Portable fundus photograph
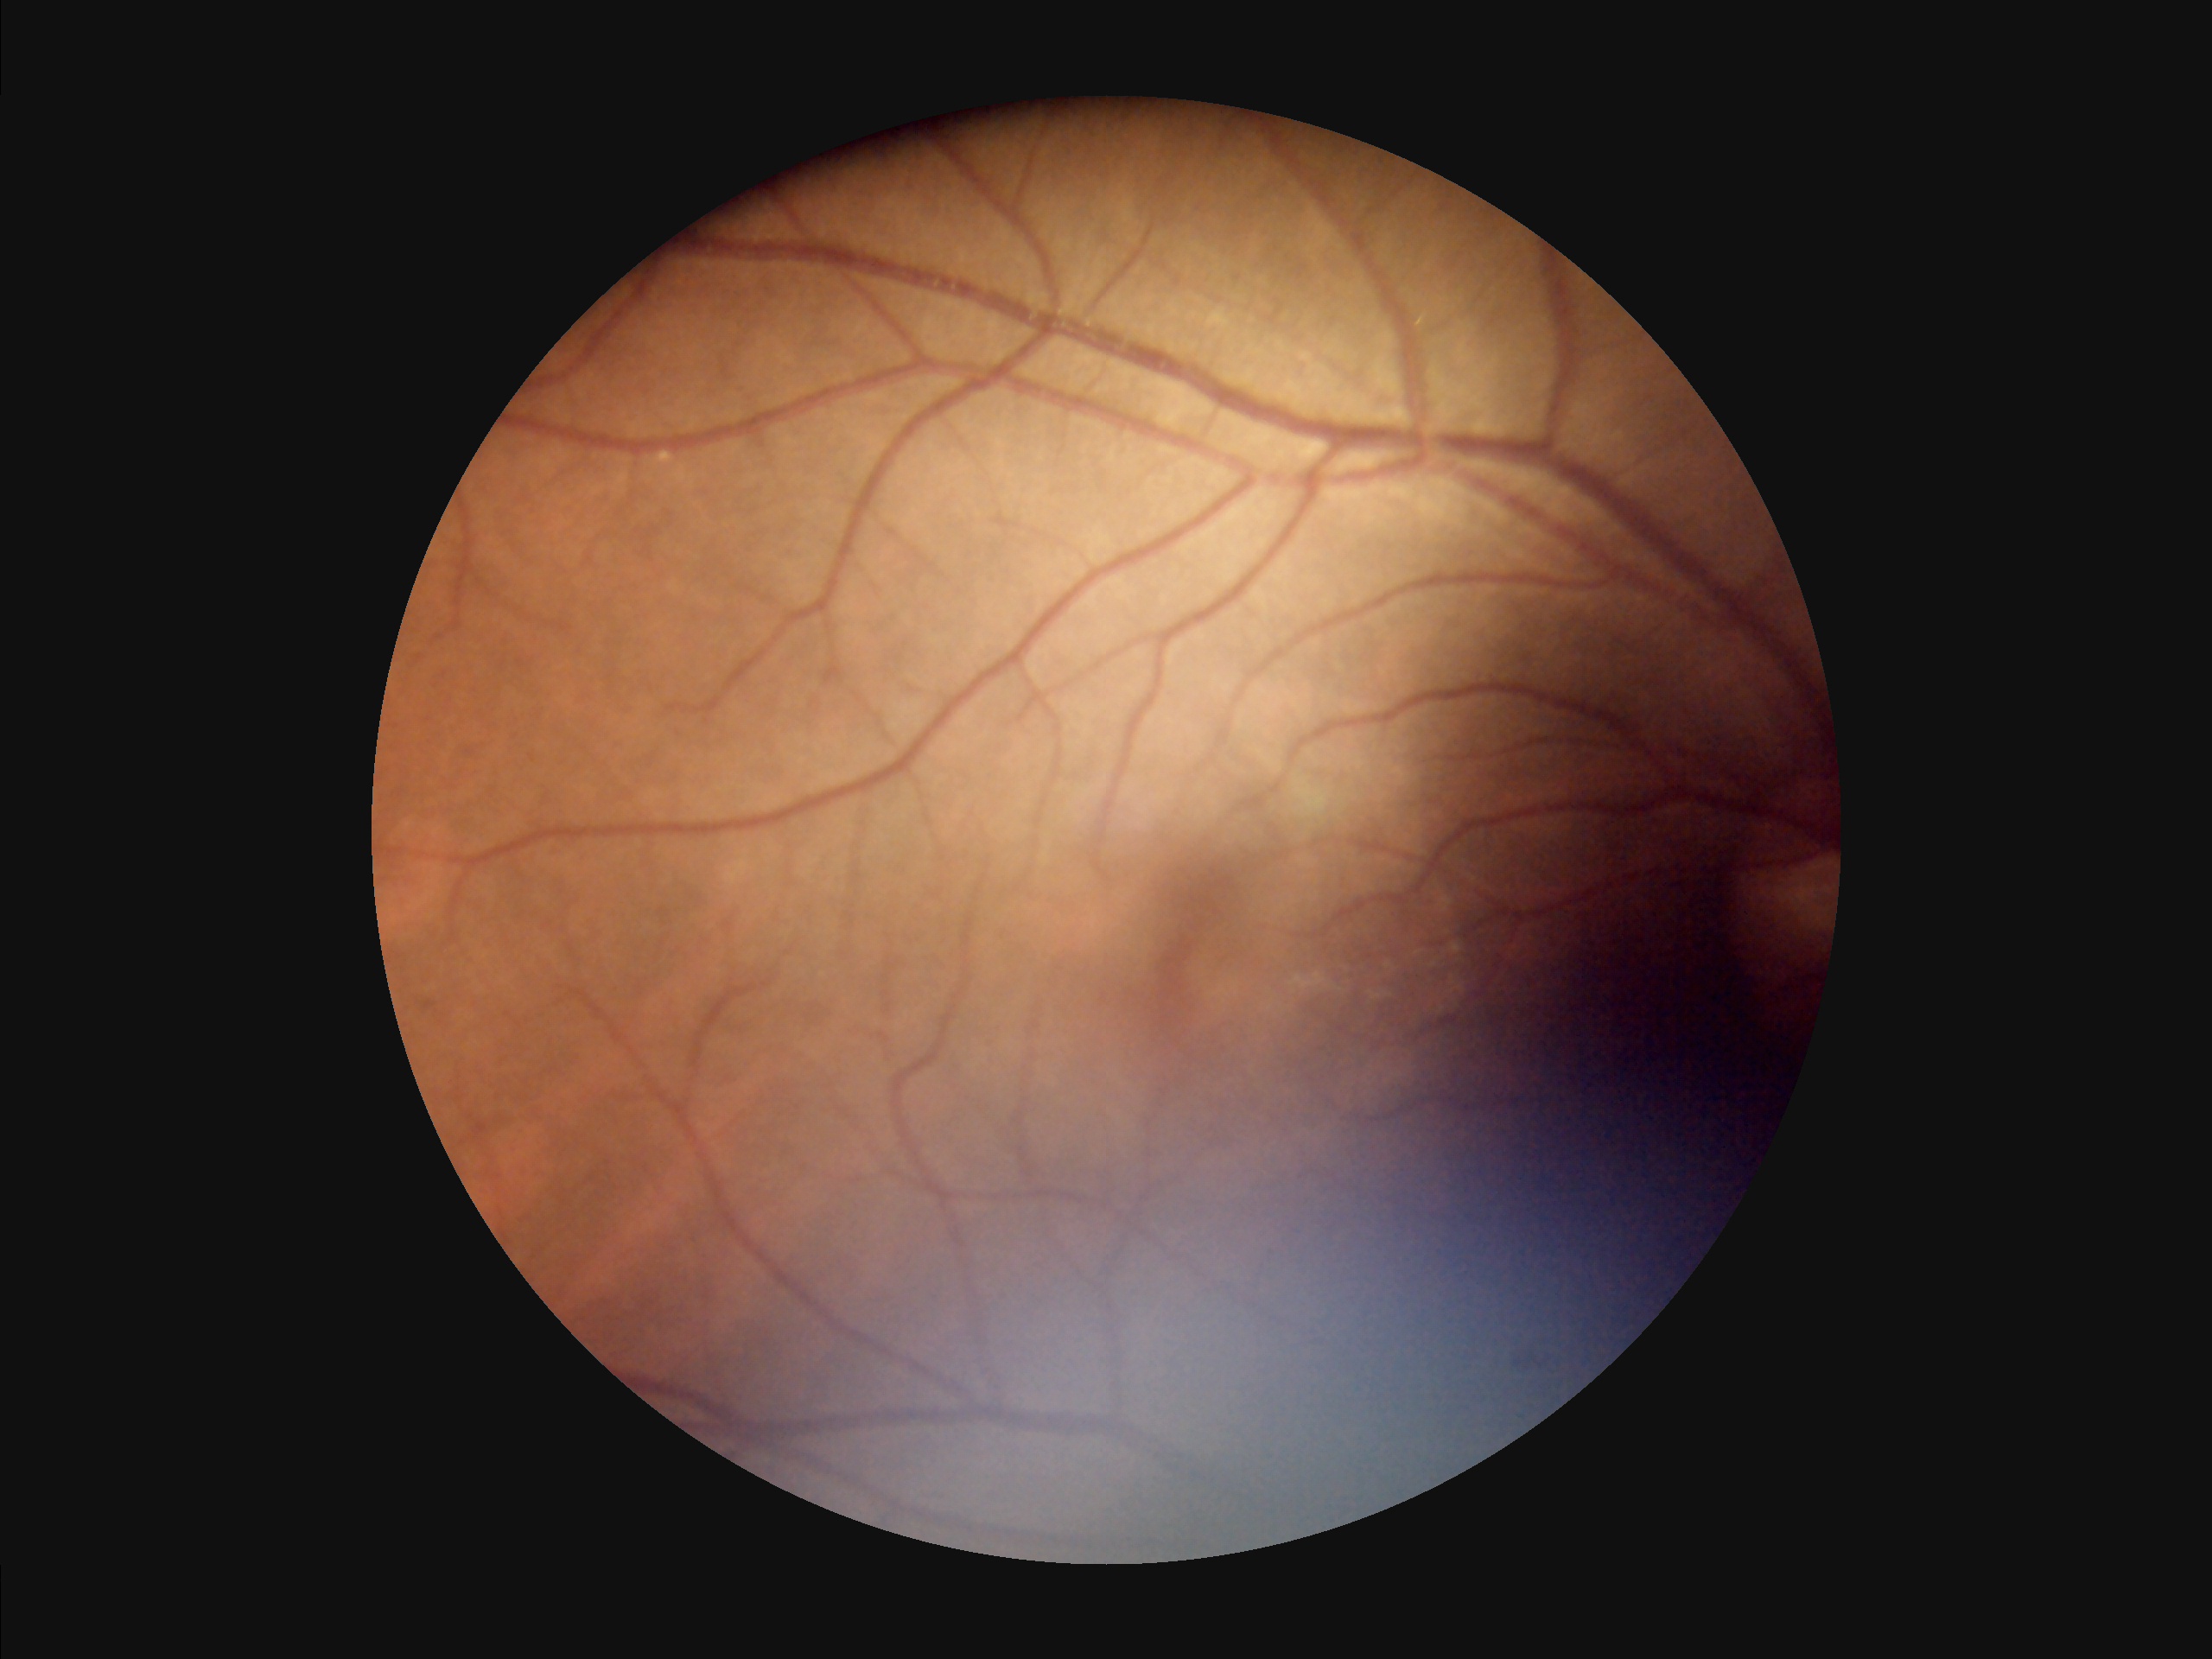

overall_quality: low
illumination: poor
contrast: satisfactory
clarity: clear